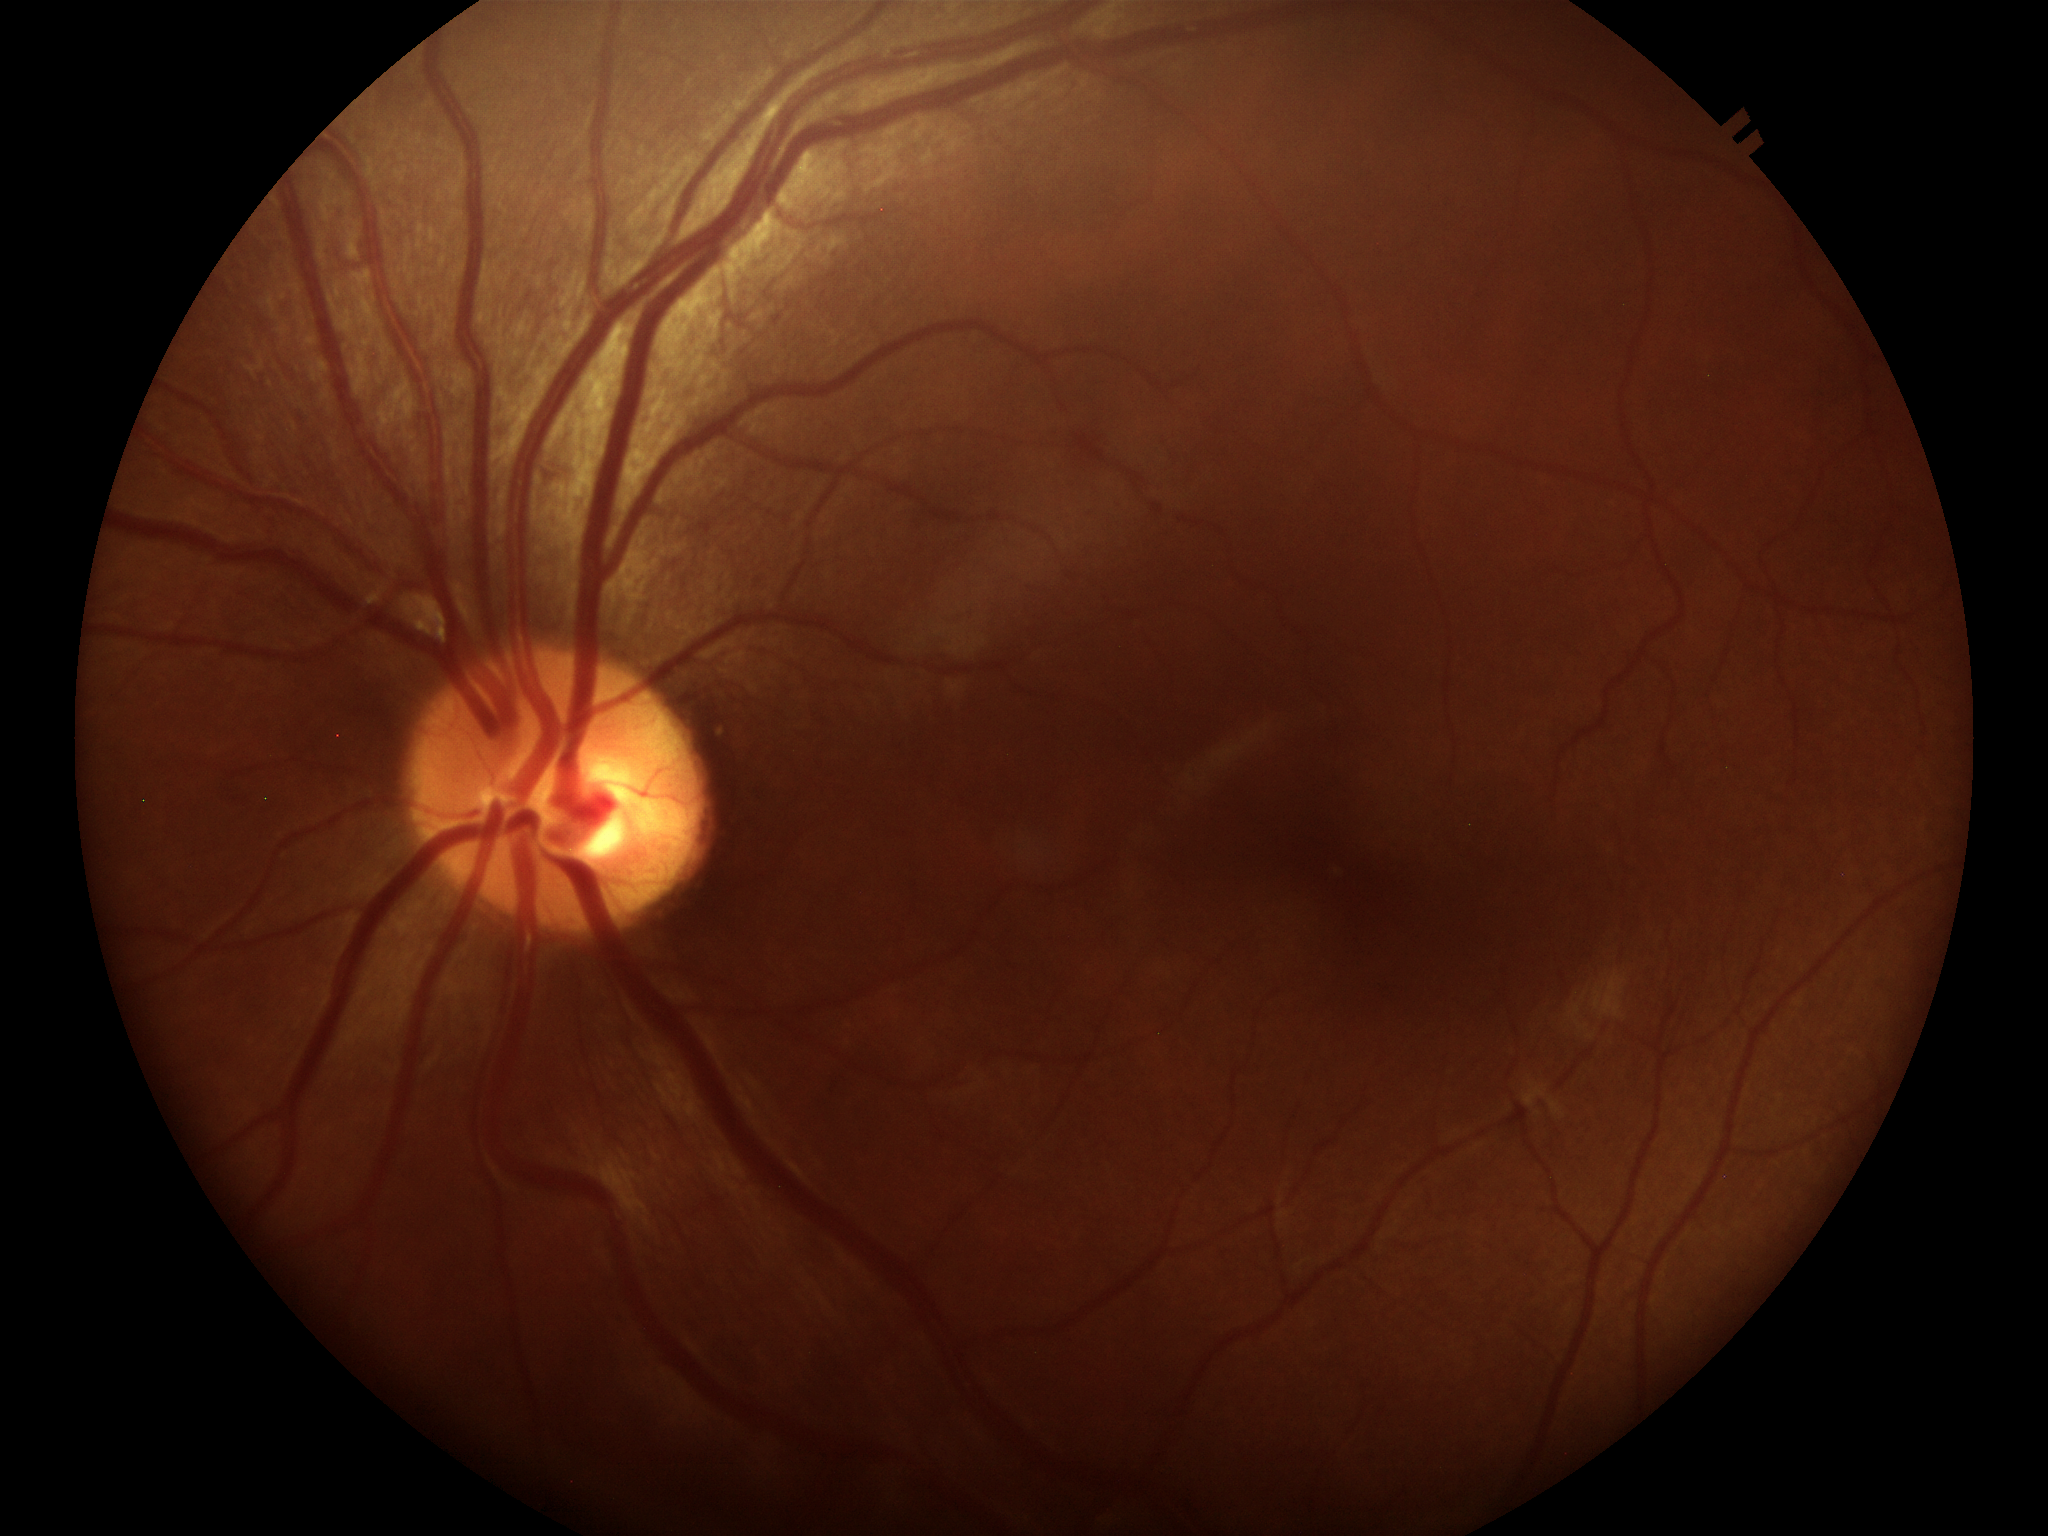
No glaucomatous optic neuropathy.
Vertical C/D ratio is 0.45.
Horizontal CDR: 0.48.